1240 x 1240 pixels · wide-field fundus photograph of an infant · acquired on the Phoenix ICON.
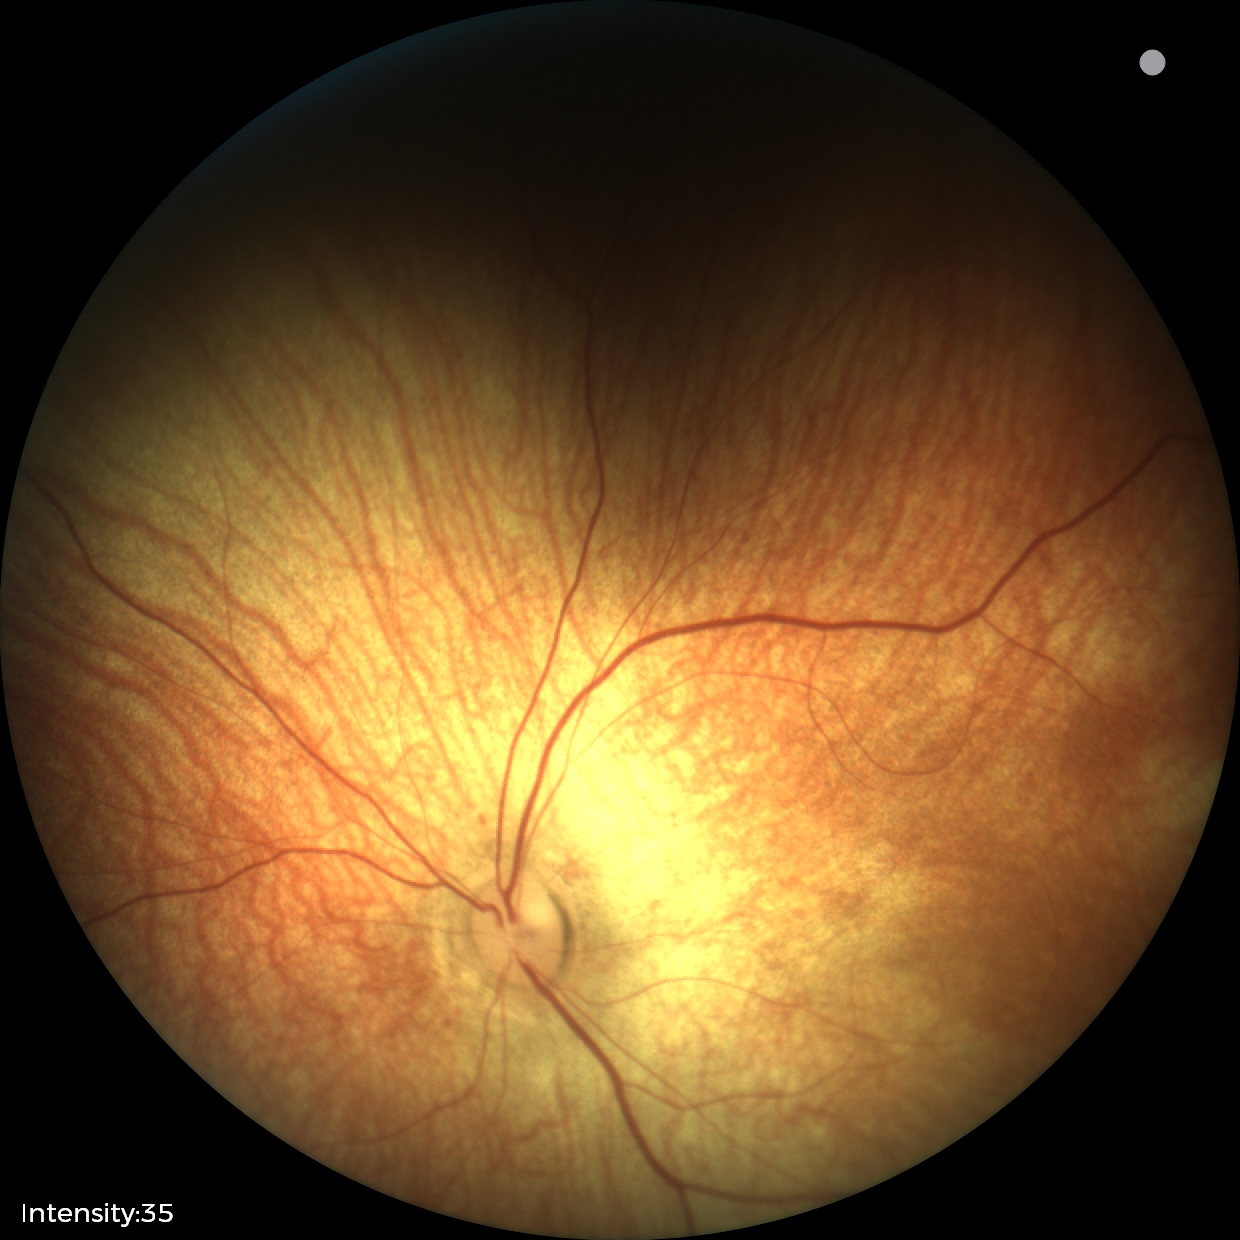 Normal screening examination.